CFP · 2352 x 1568 pixels · FOV: 45 degrees — 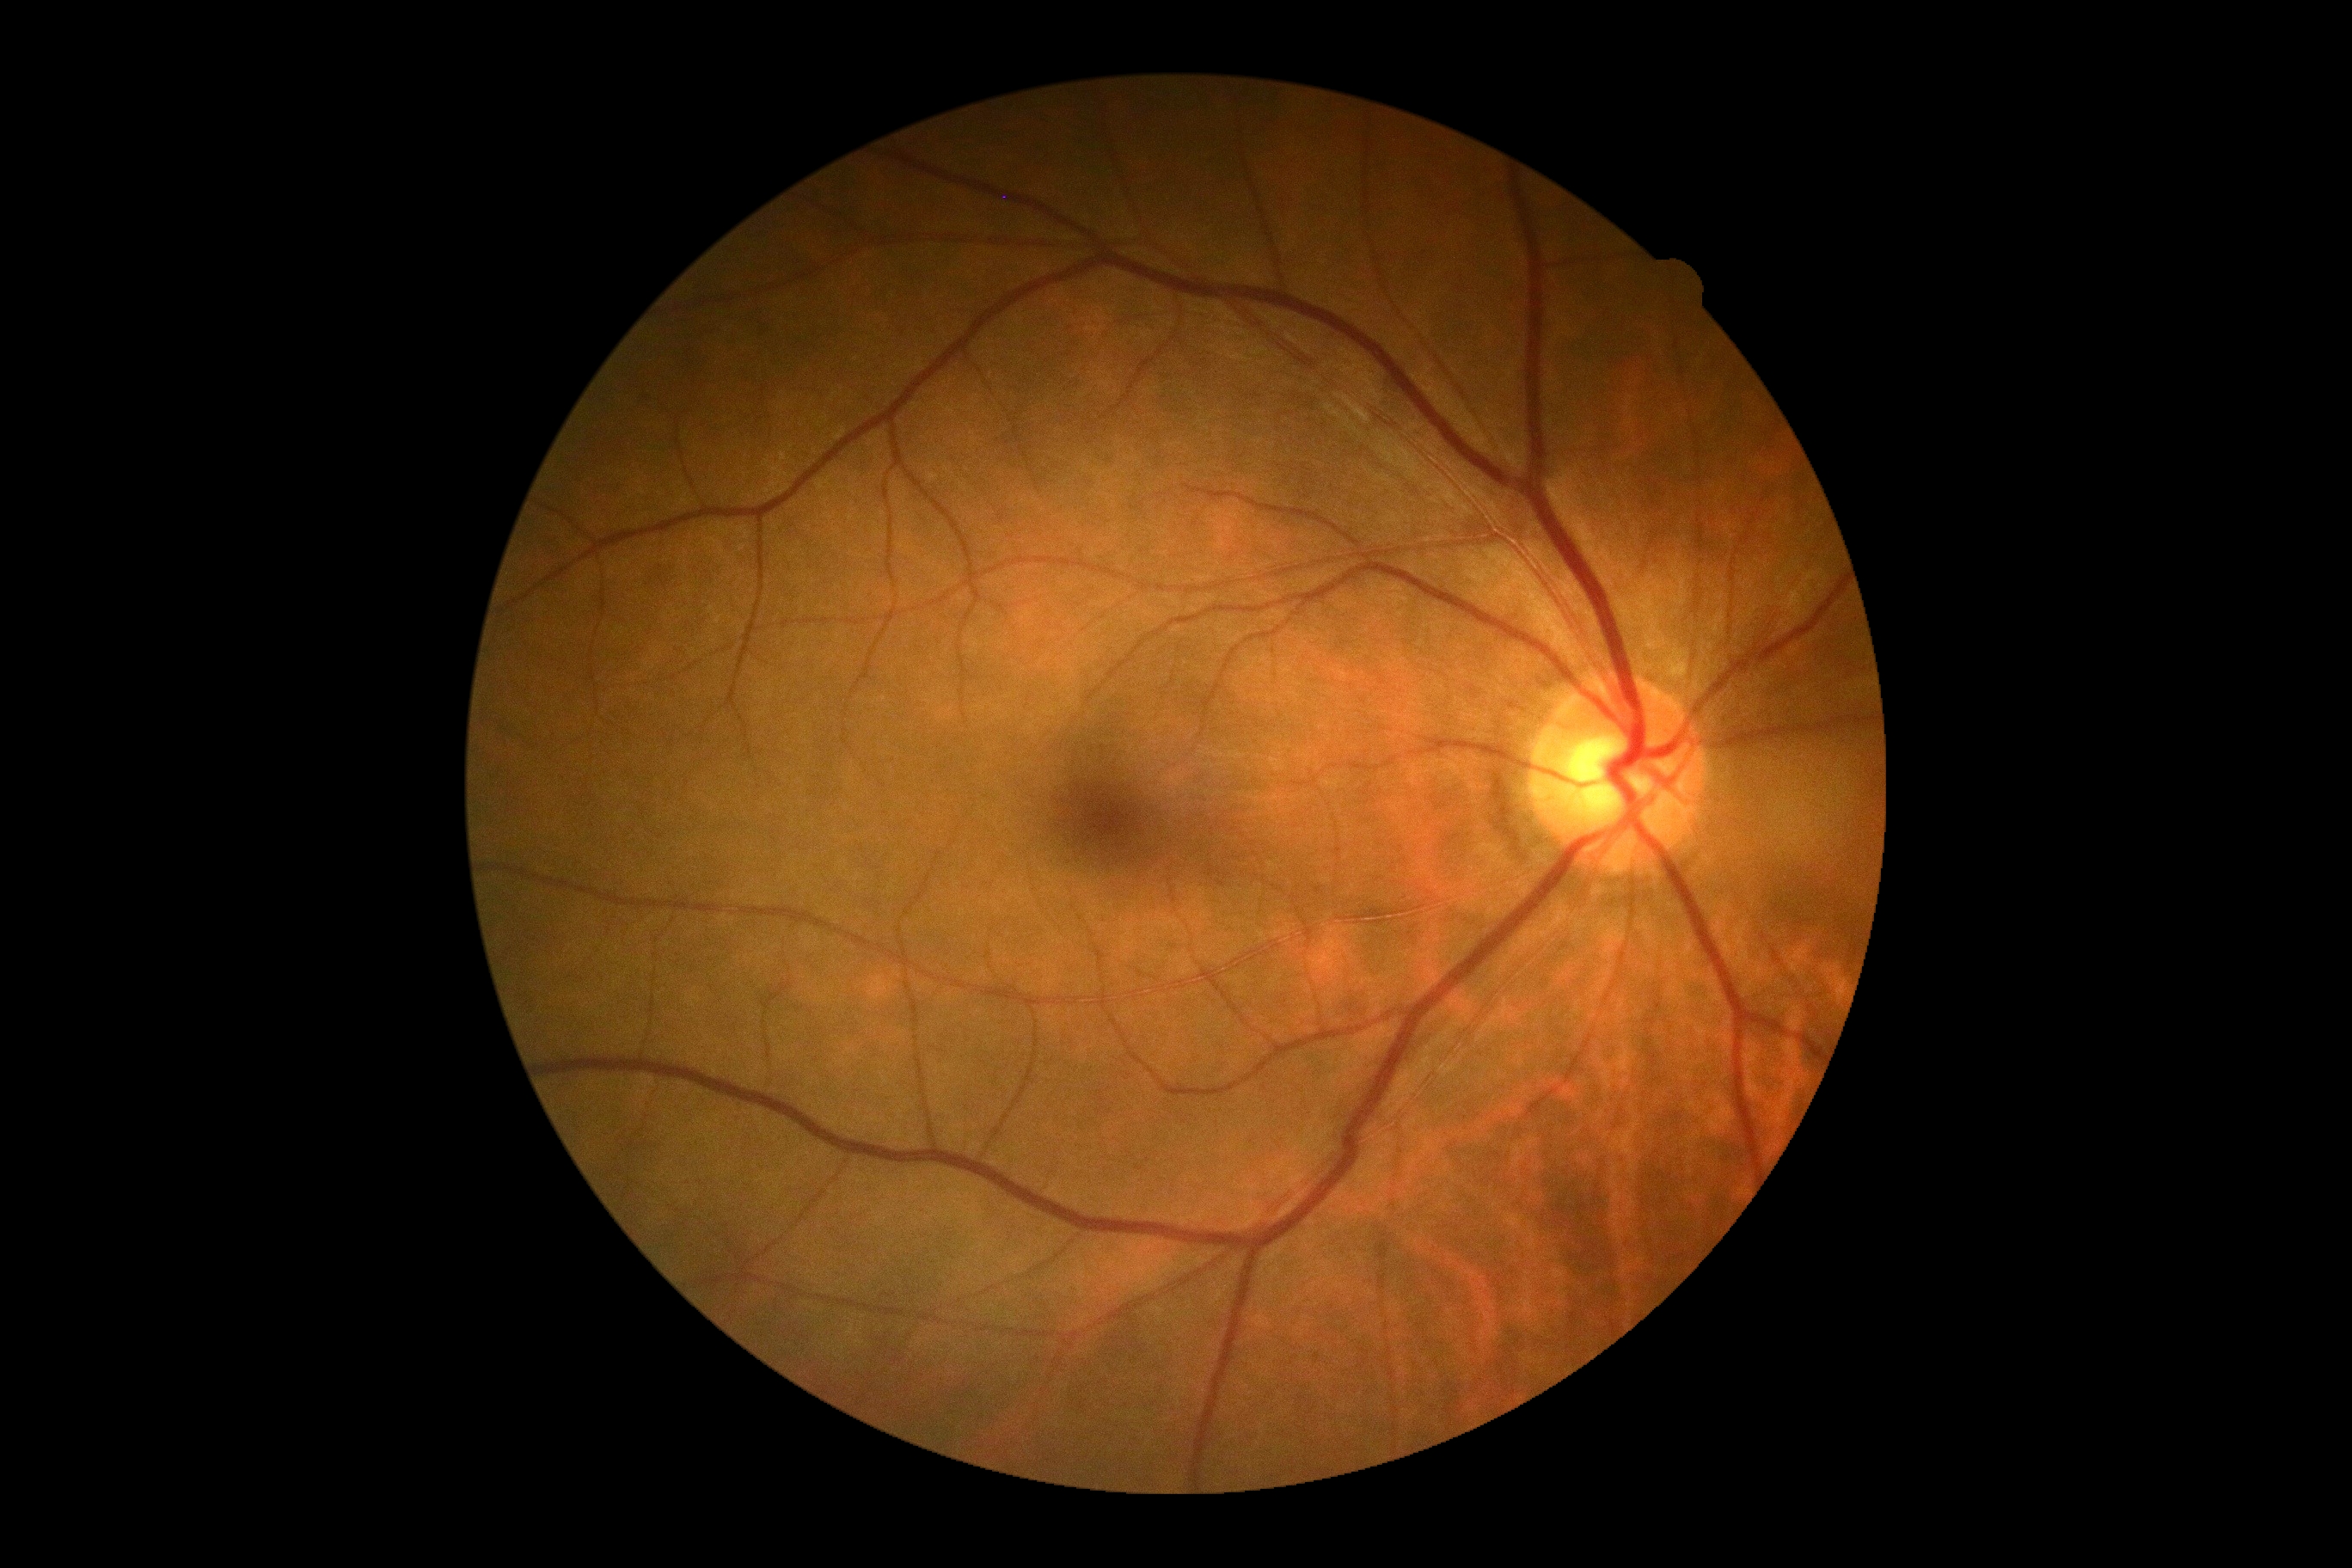

diabetic retinopathy (DR): 0/4 — no visible signs of diabetic retinopathy, DR impression: negative for DR.